45° field of view.
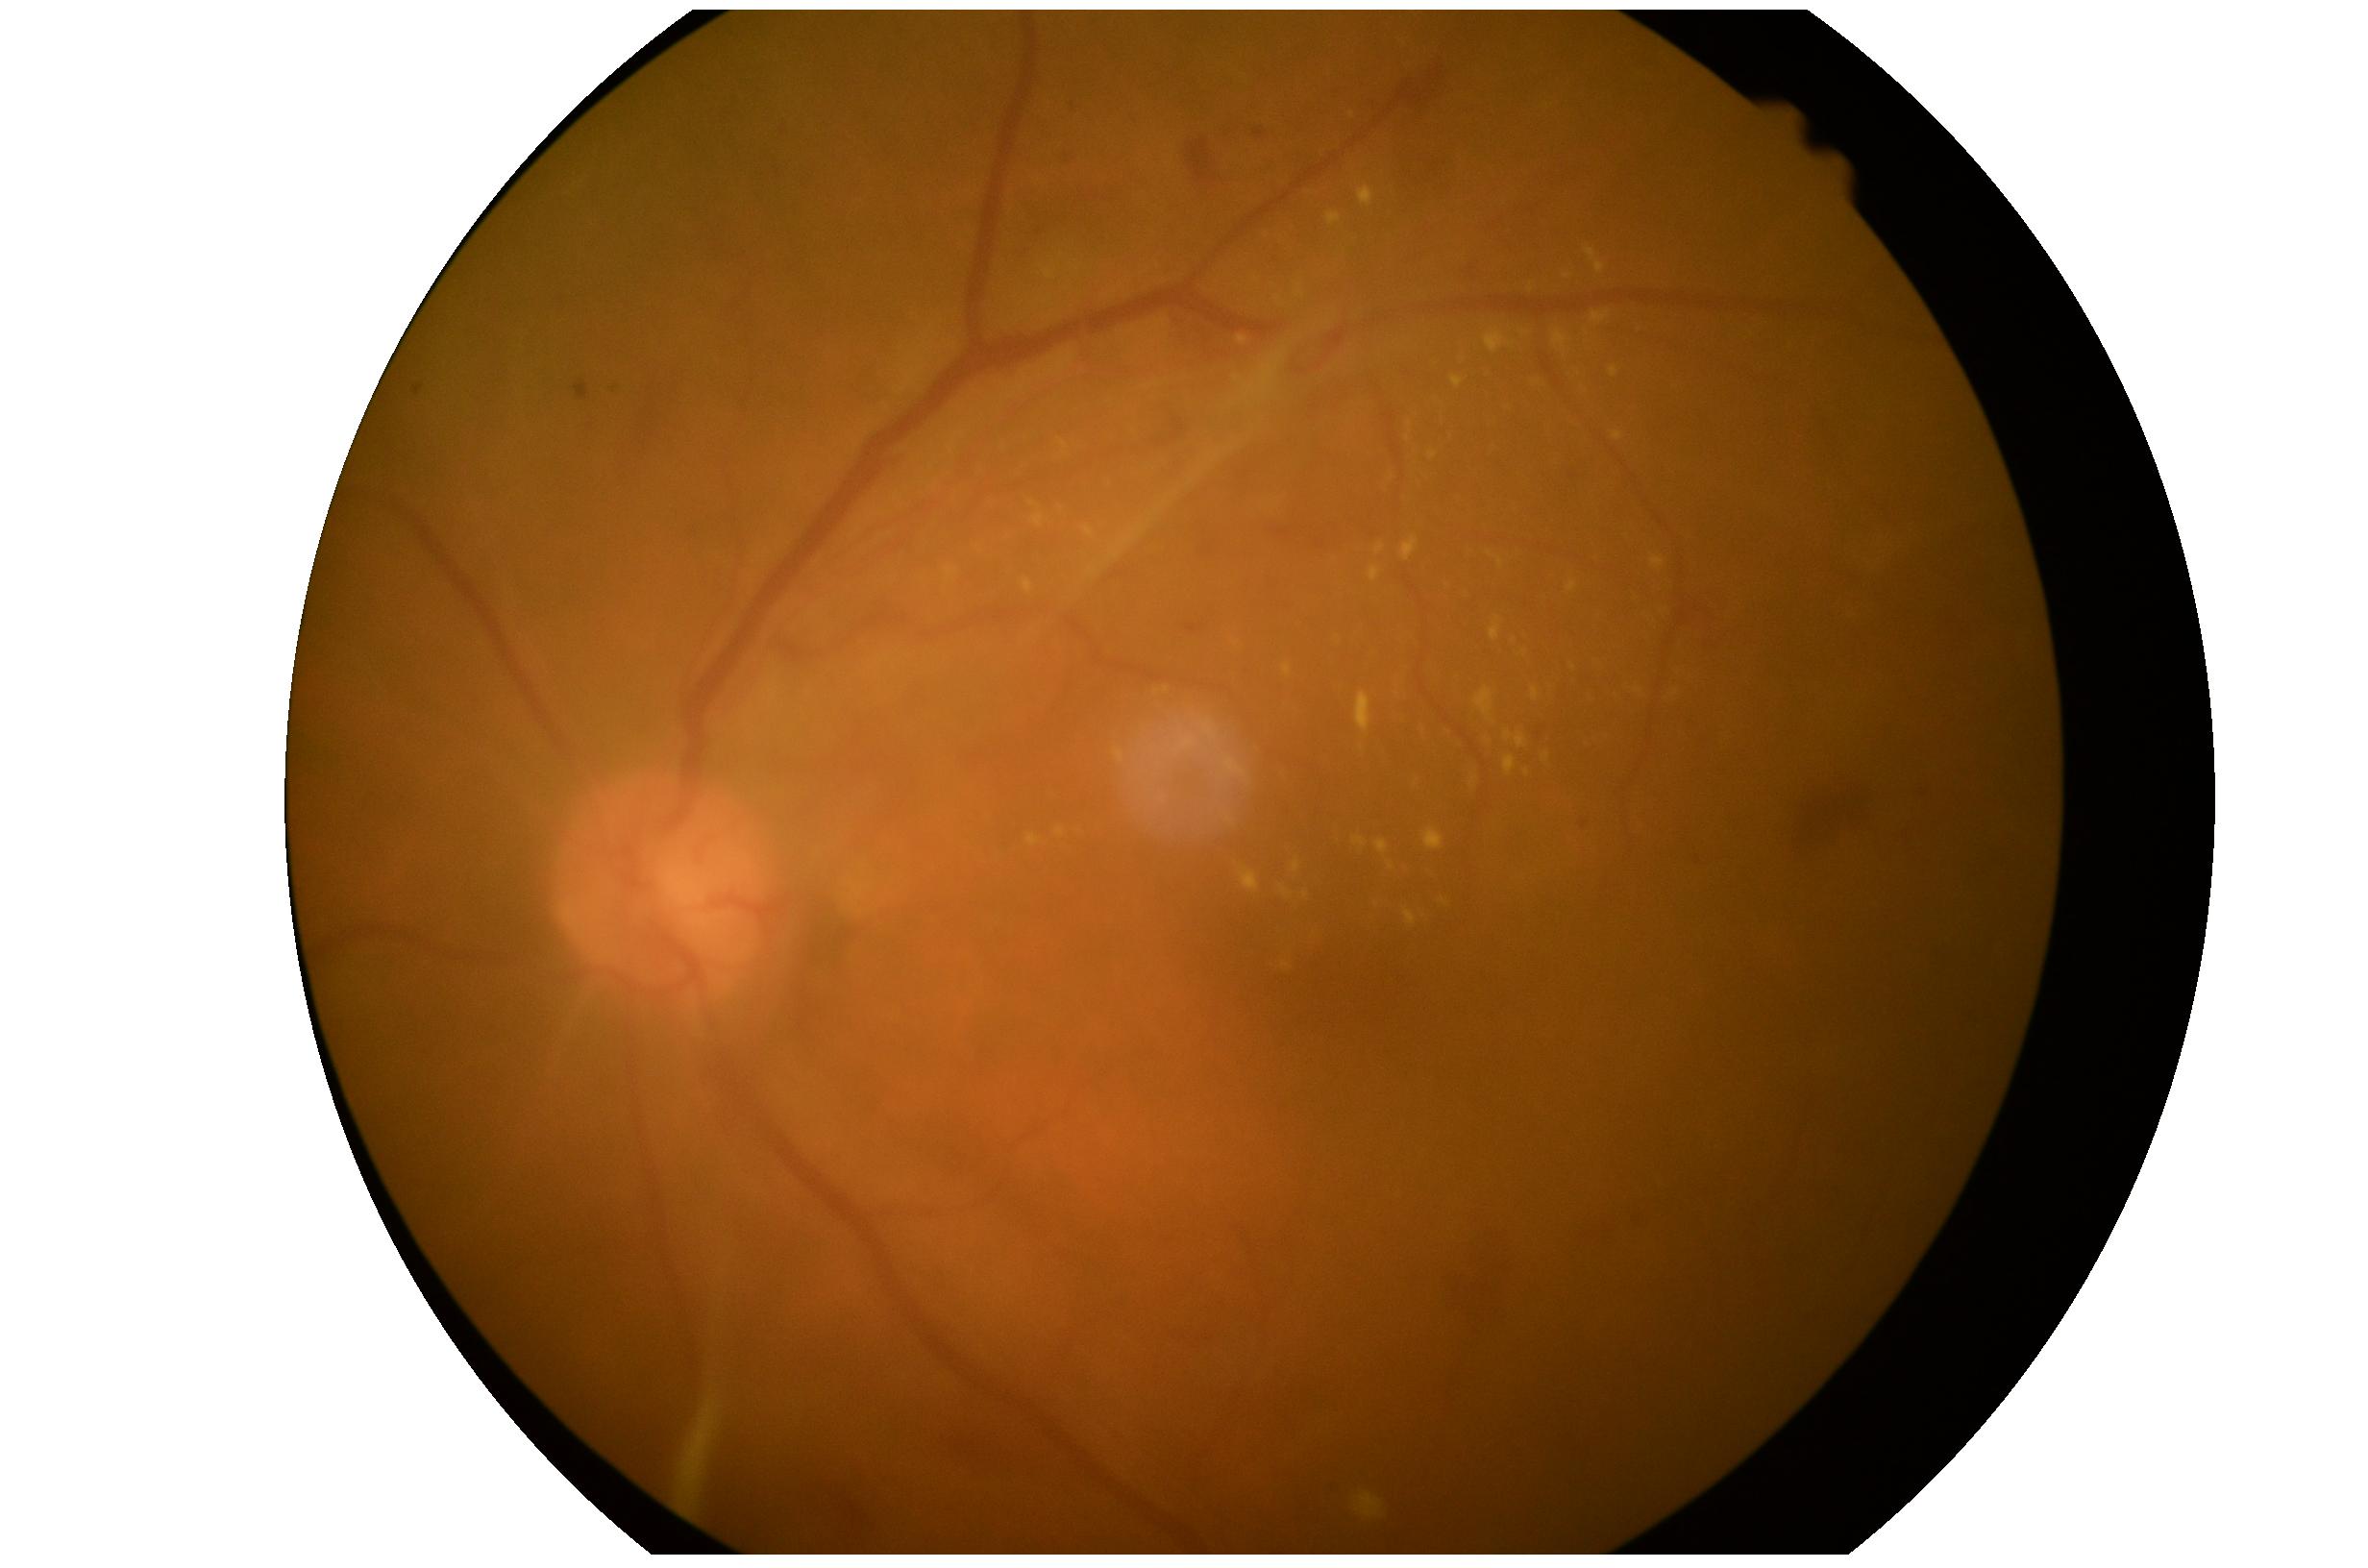

DR is 4/4.